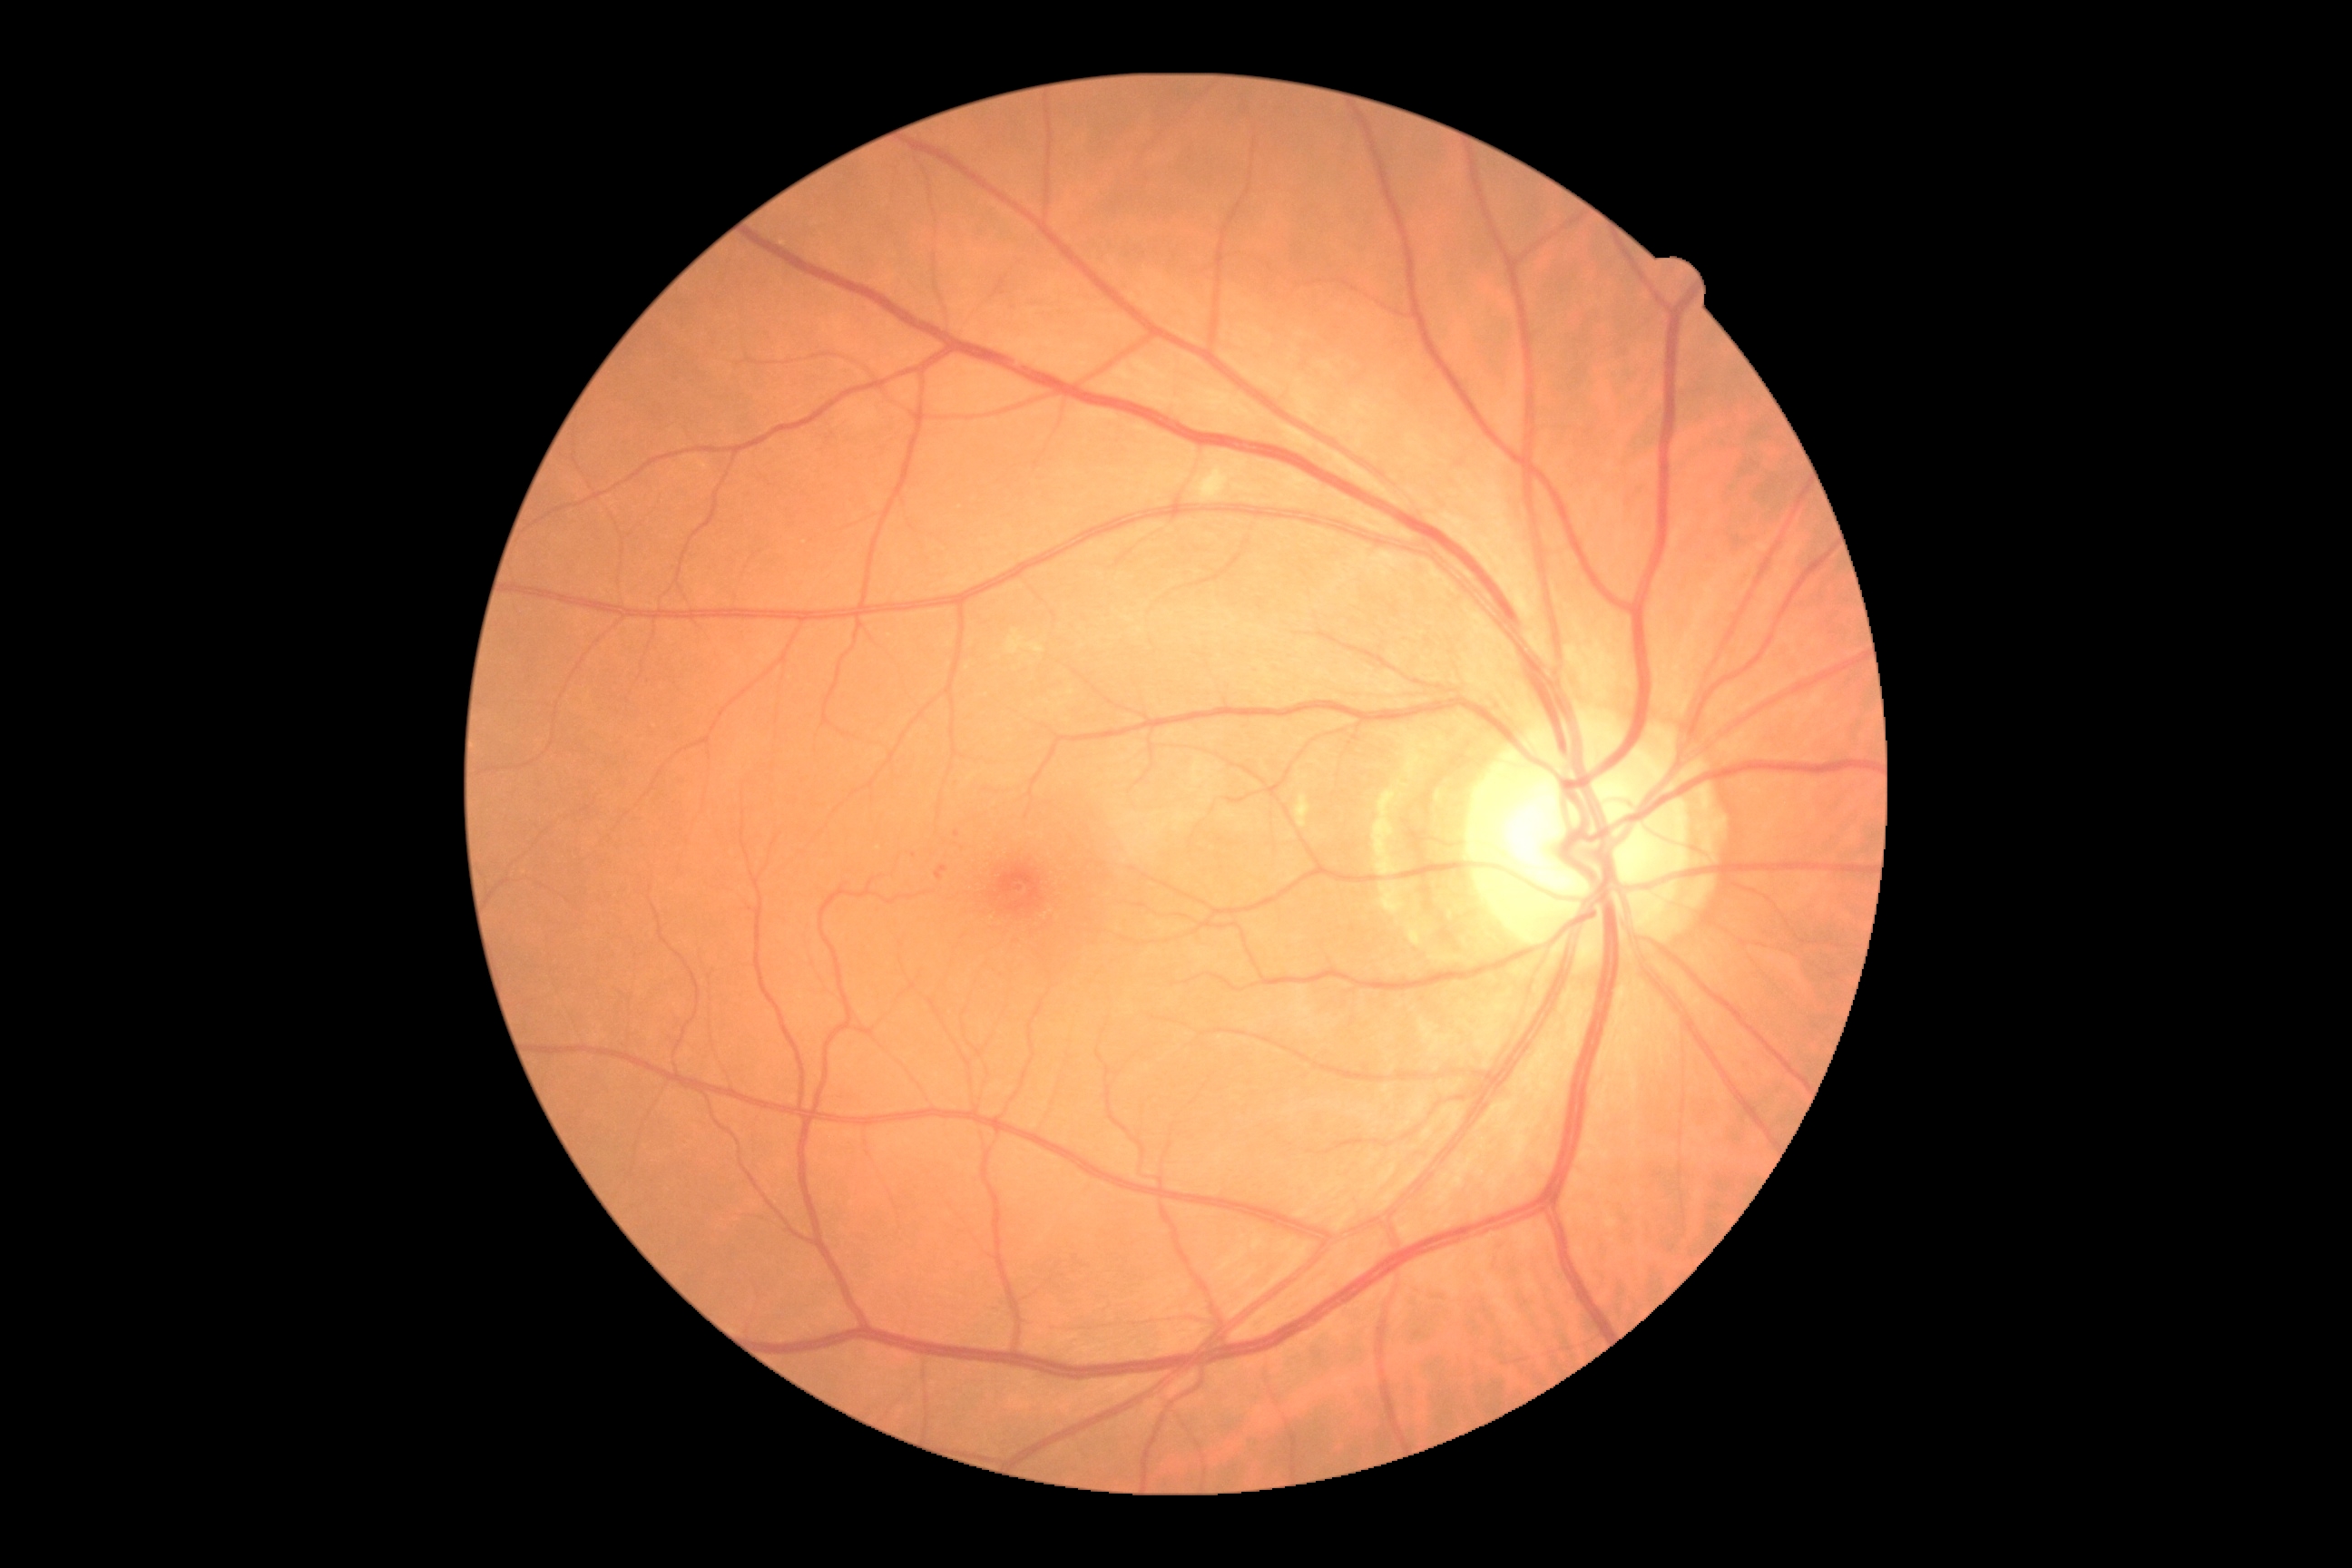

DR grade=2/4.